Image size 2352x1568.
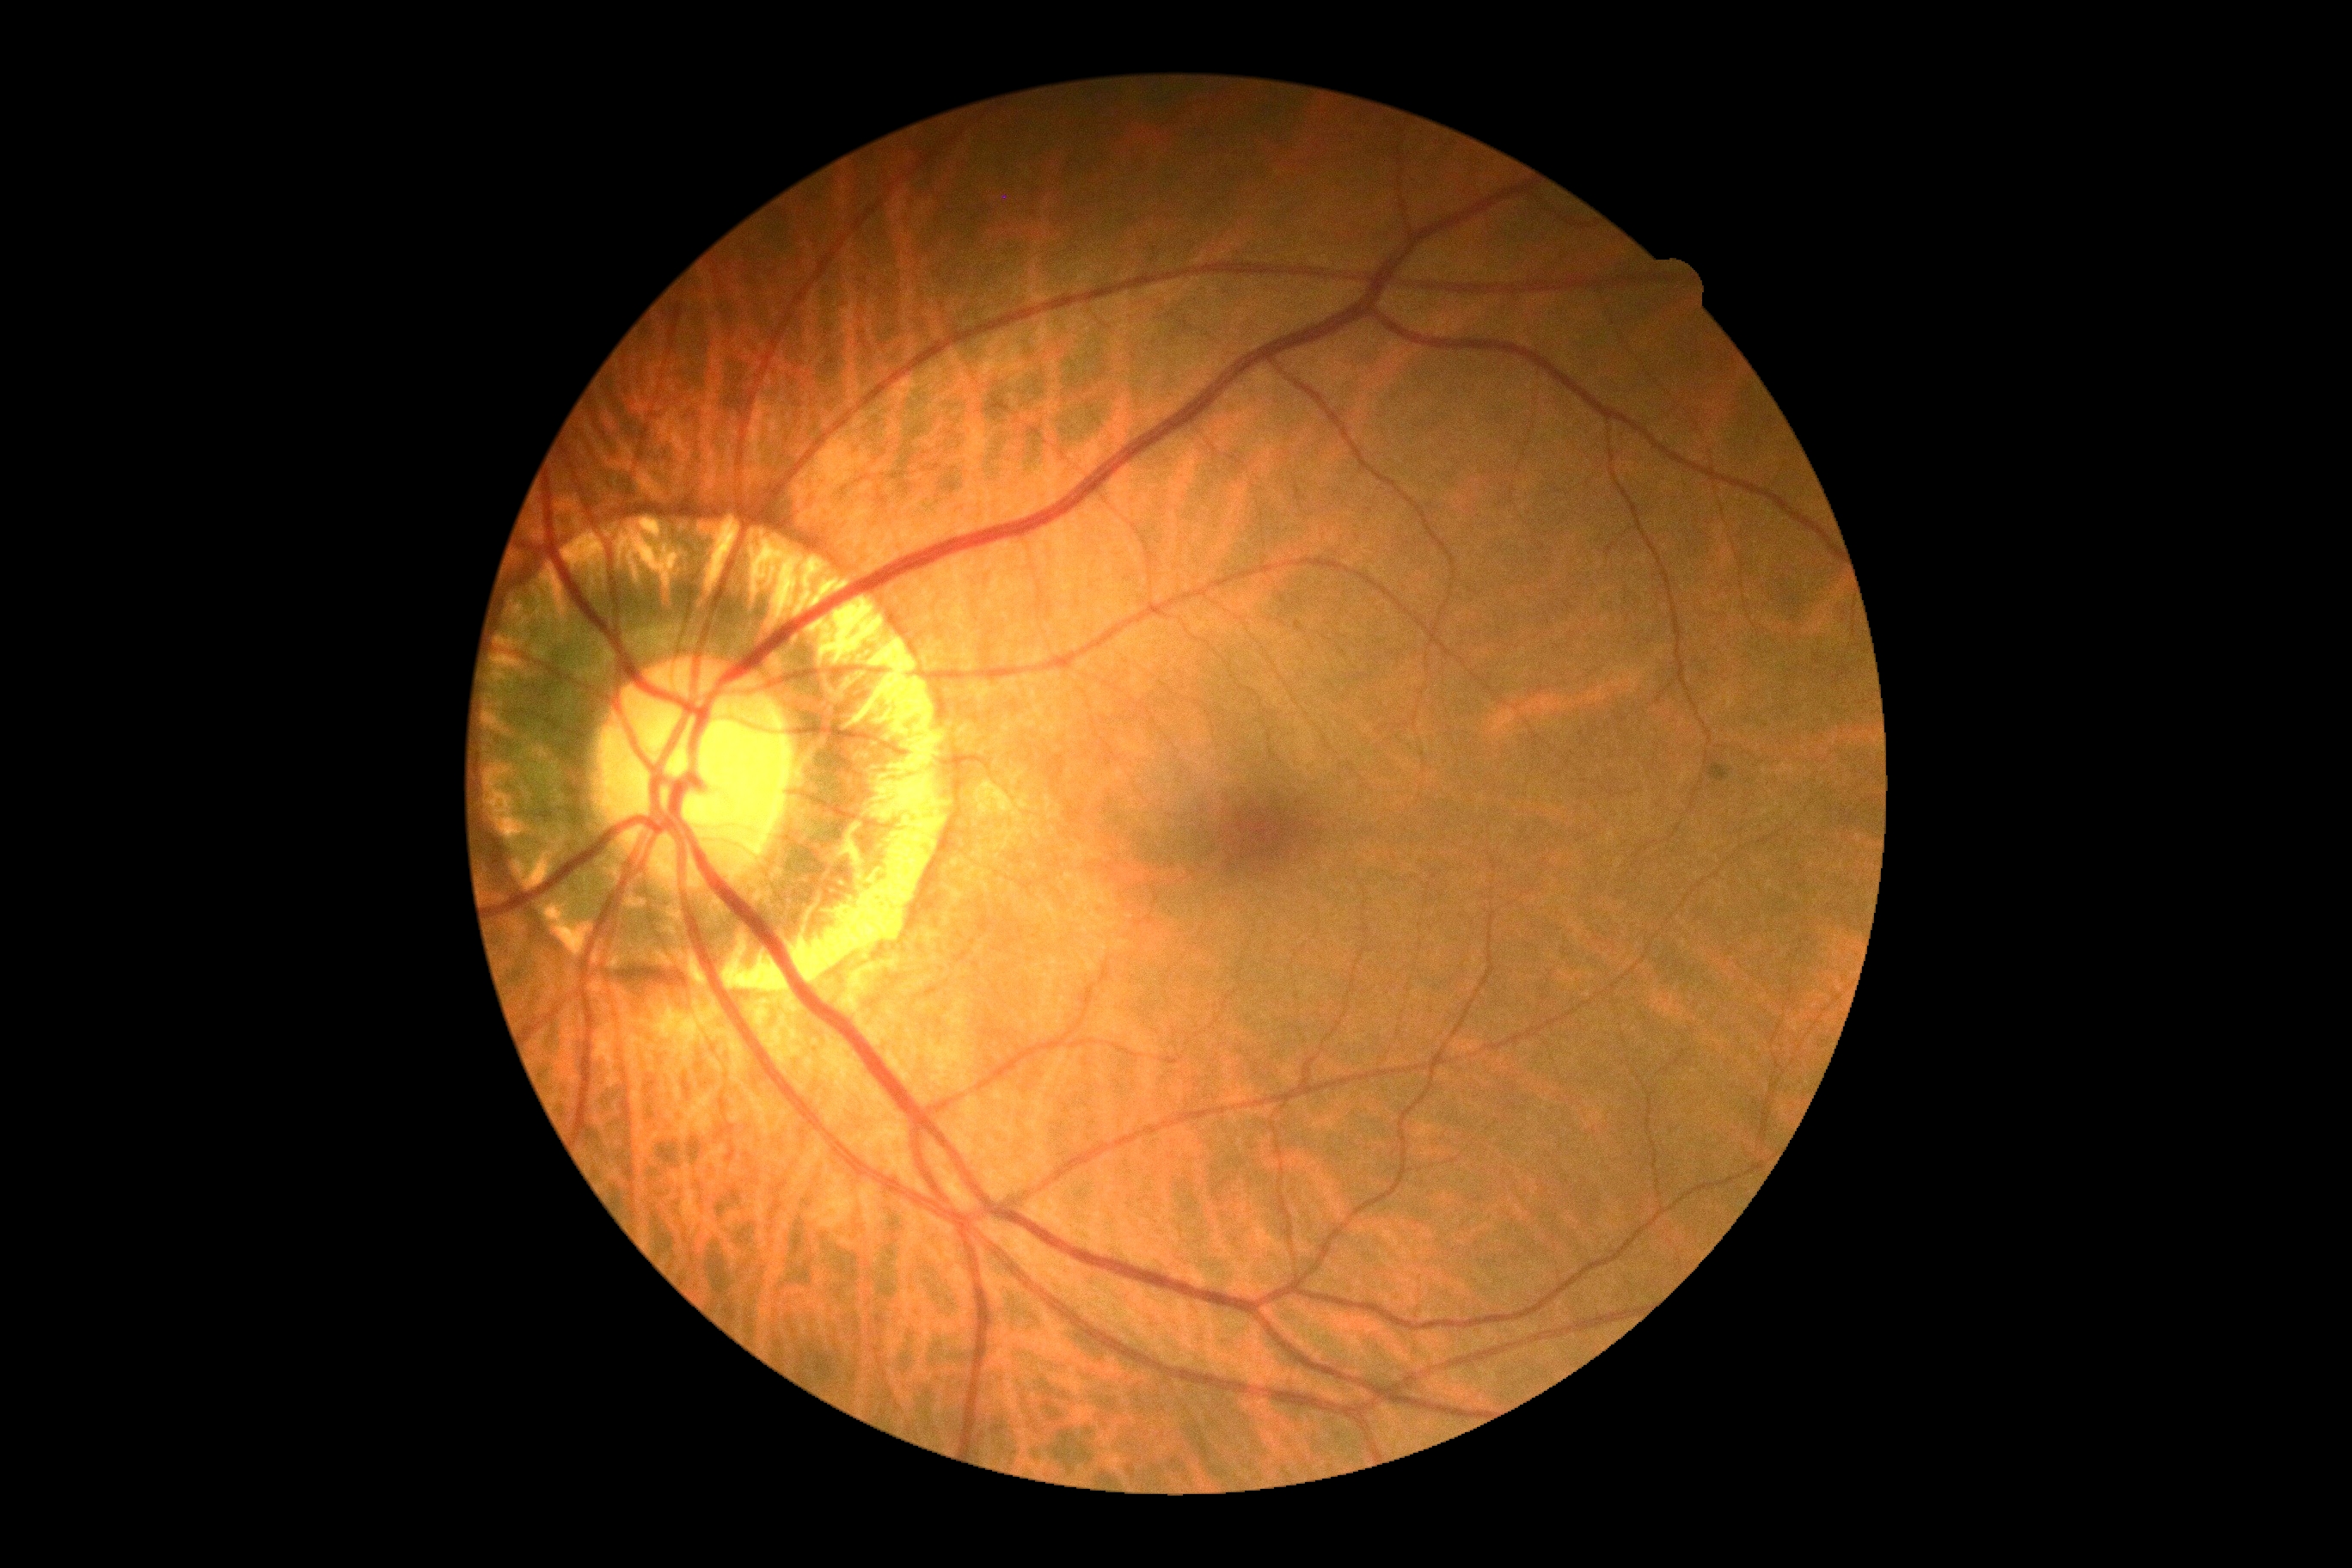 DR impression=no signs of DR, DR grade=0 (no apparent retinopathy) — no visible signs of diabetic retinopathy.